1659x2212px; Remidio smartphone fundus camera
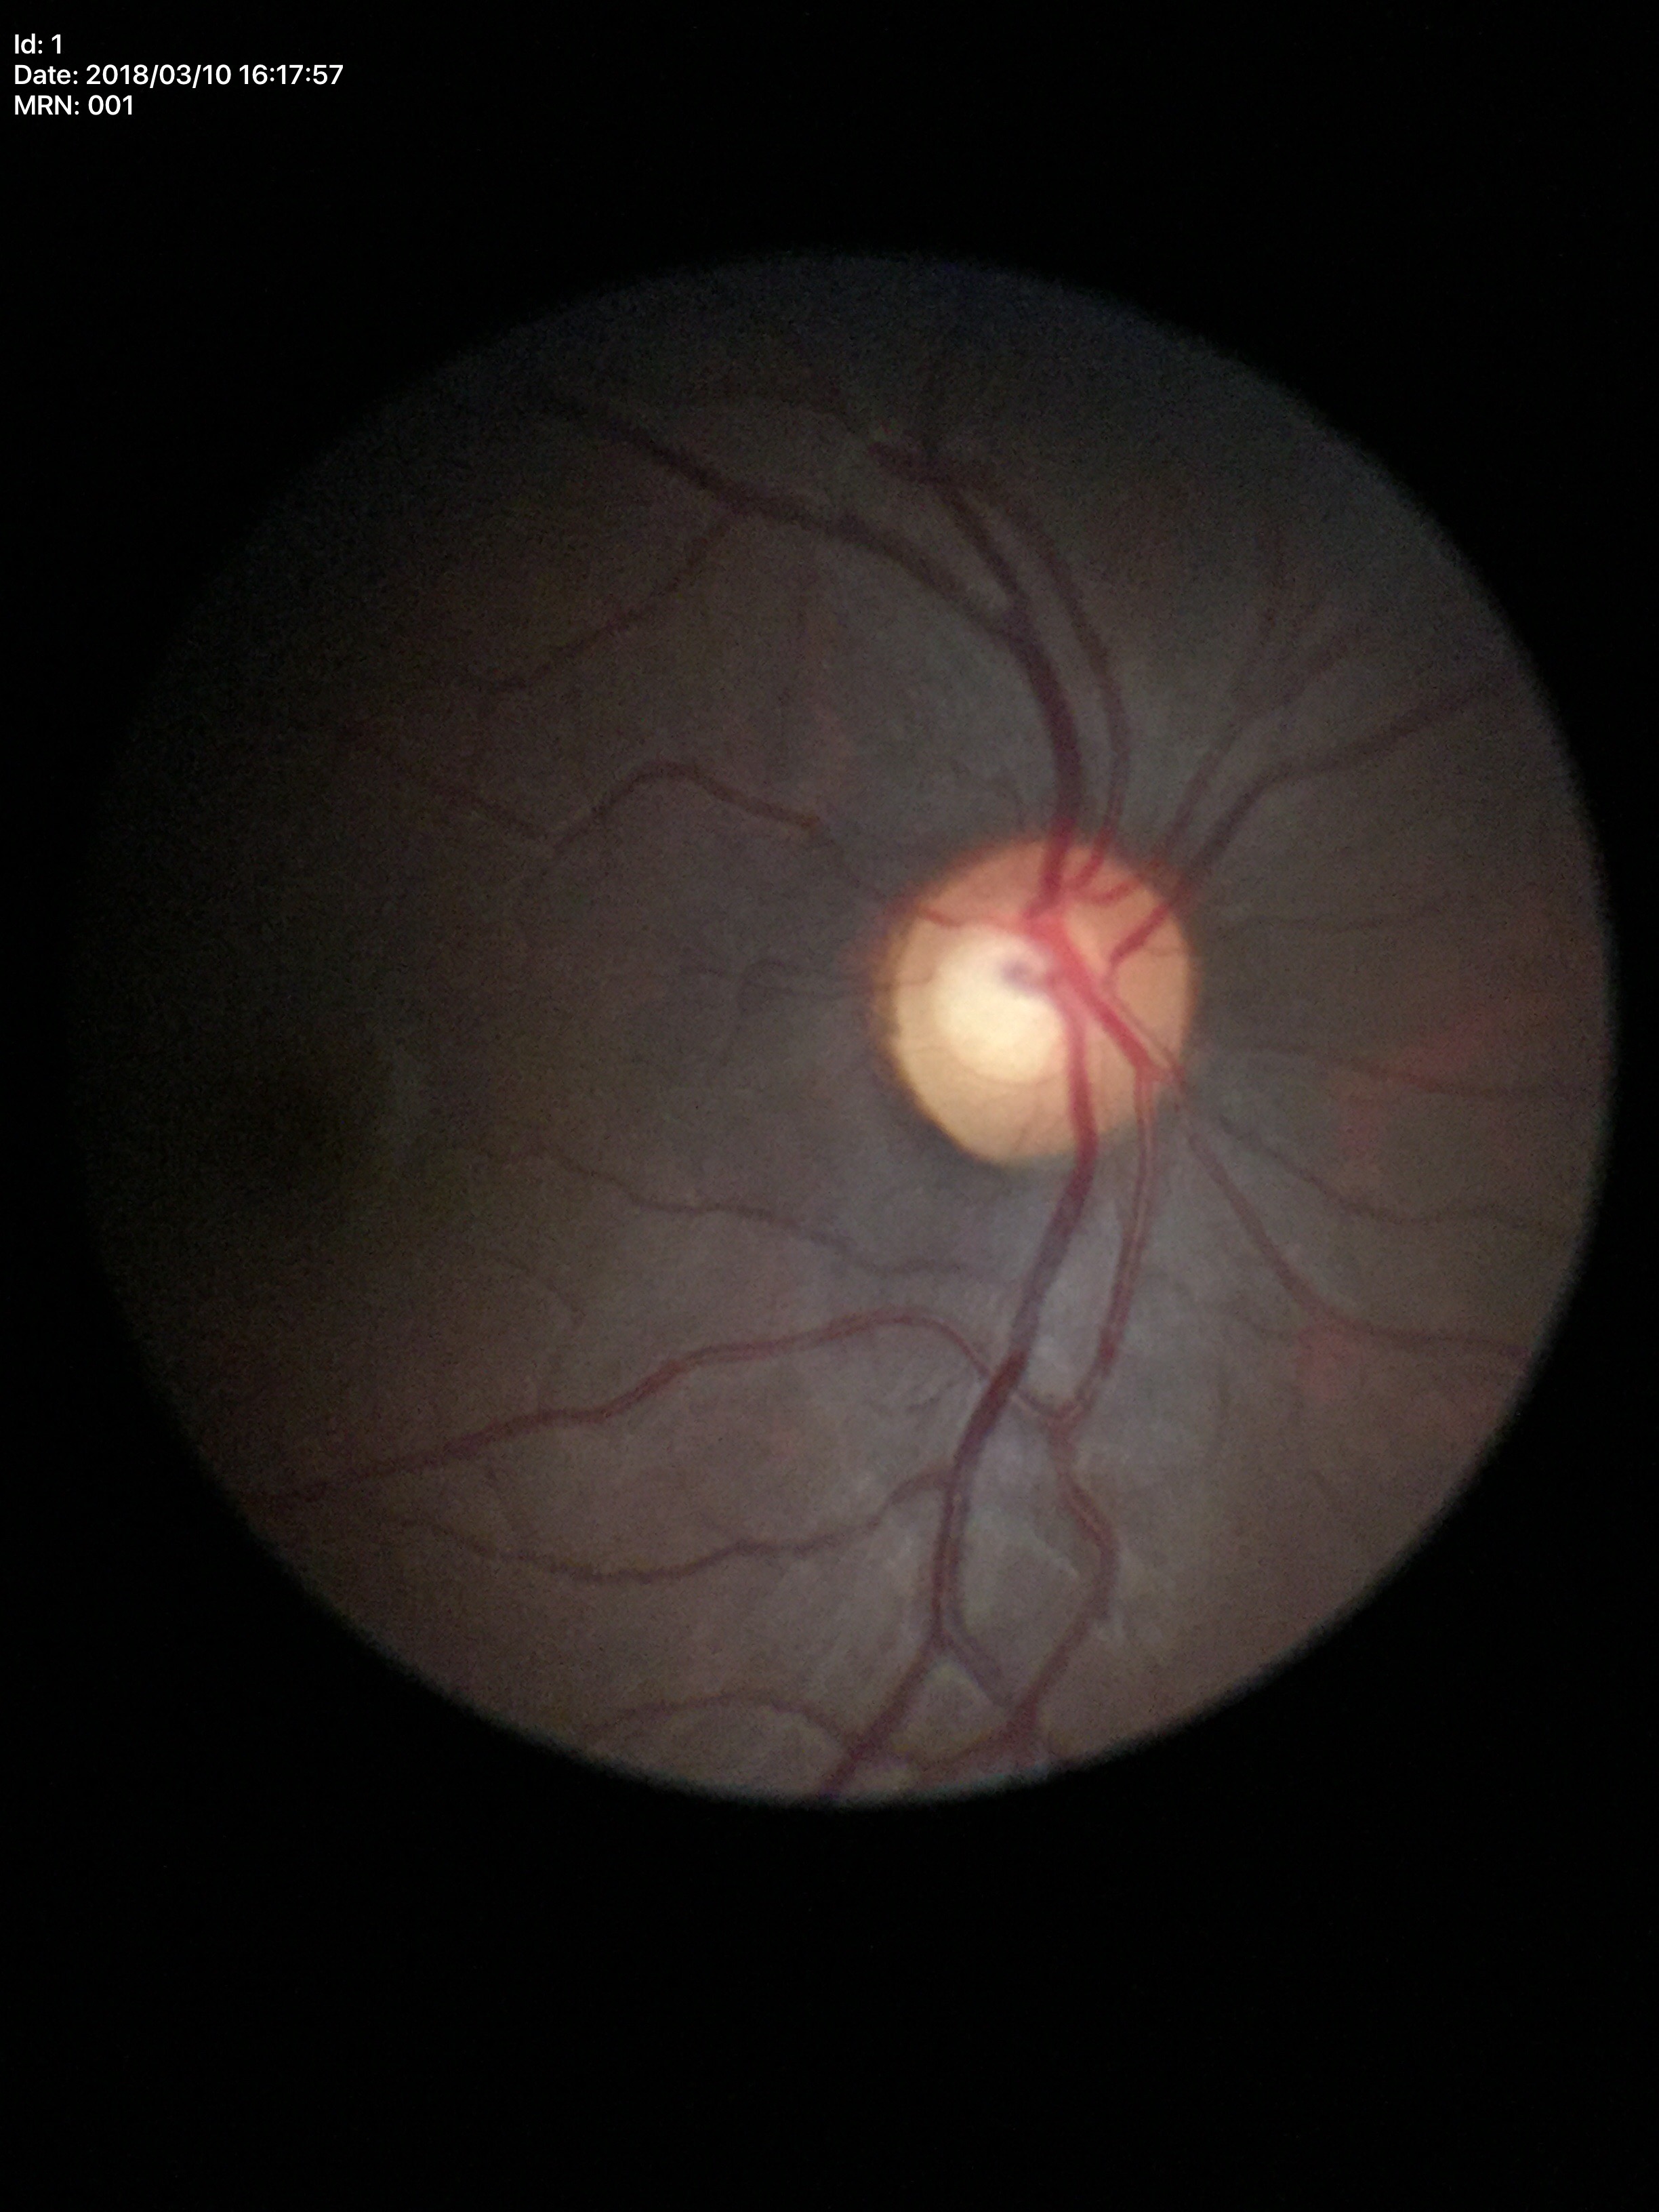

Horizontal C/D ratio (HCDR) is 0.63.
Glaucoma evaluation: suspicious.
Vertical C/D ratio (VCDR): 0.61.